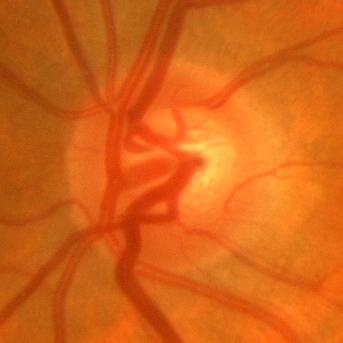

Optic nerve head photograph demonstrating no glaucoma.